Modified Davis grading; 45 degree fundus photograph; retinal fundus photograph:
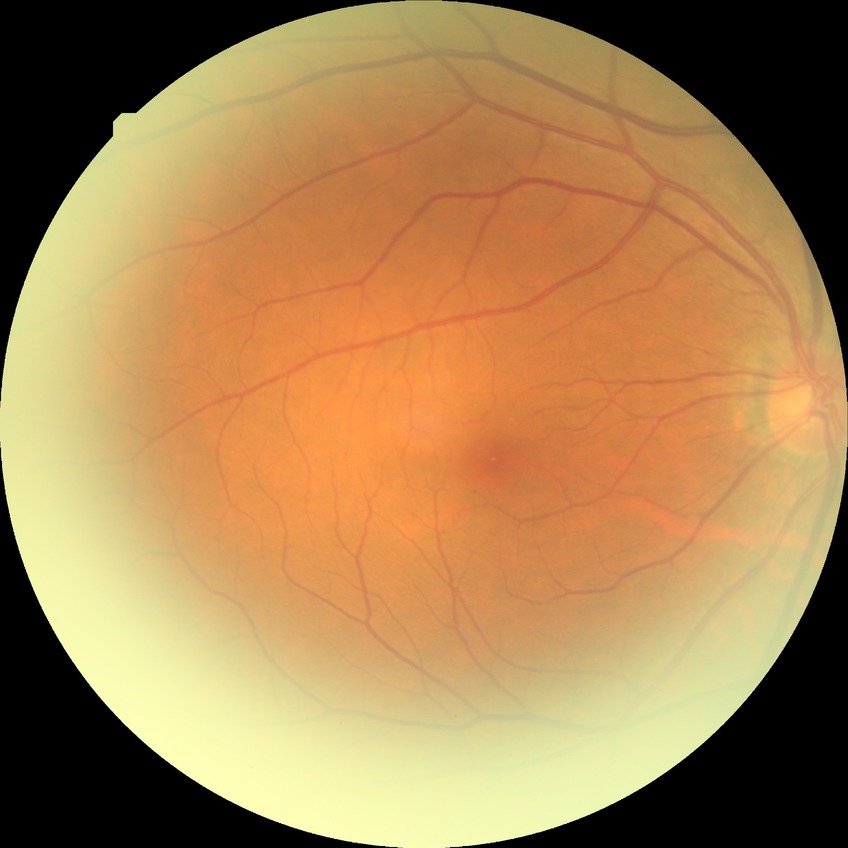

Assessment:
– retinopathy stage — no diabetic retinopathy